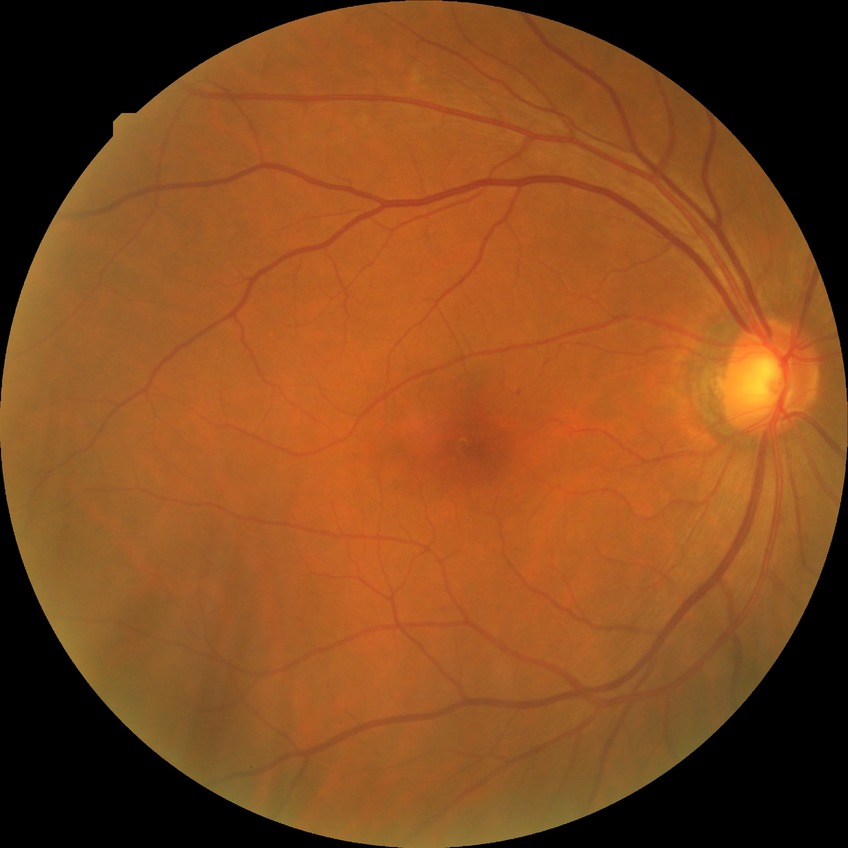
Diabetic retinopathy (DR) is SDR (simple diabetic retinopathy).